Image size 848x848:
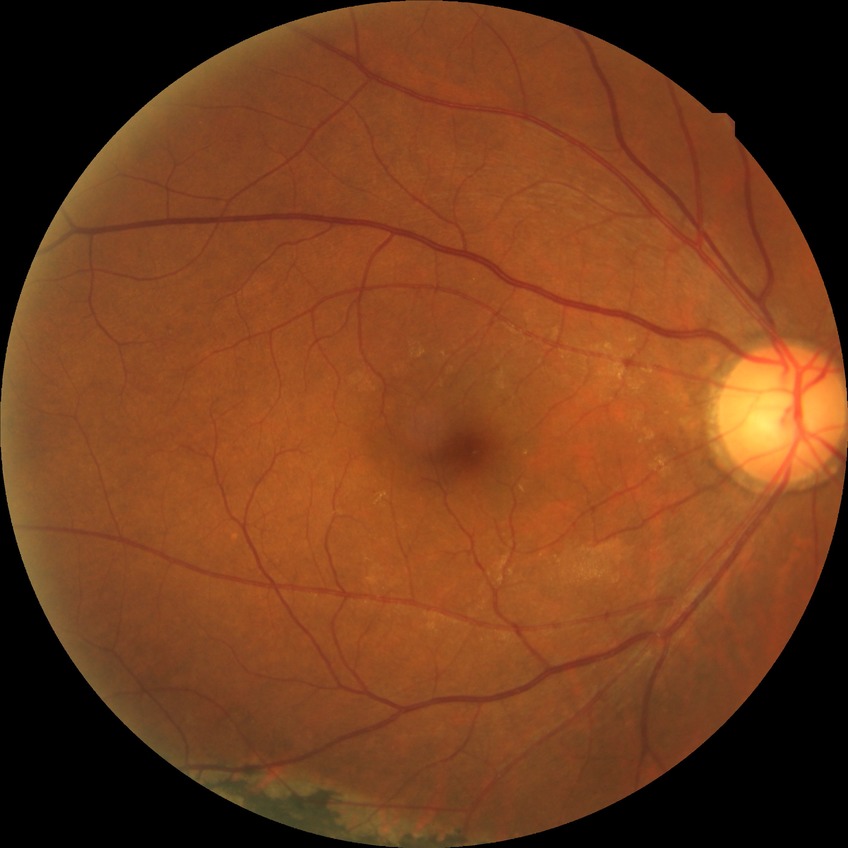 Diabetic retinopathy severity: no diabetic retinopathy.